Image size 2212x1672: 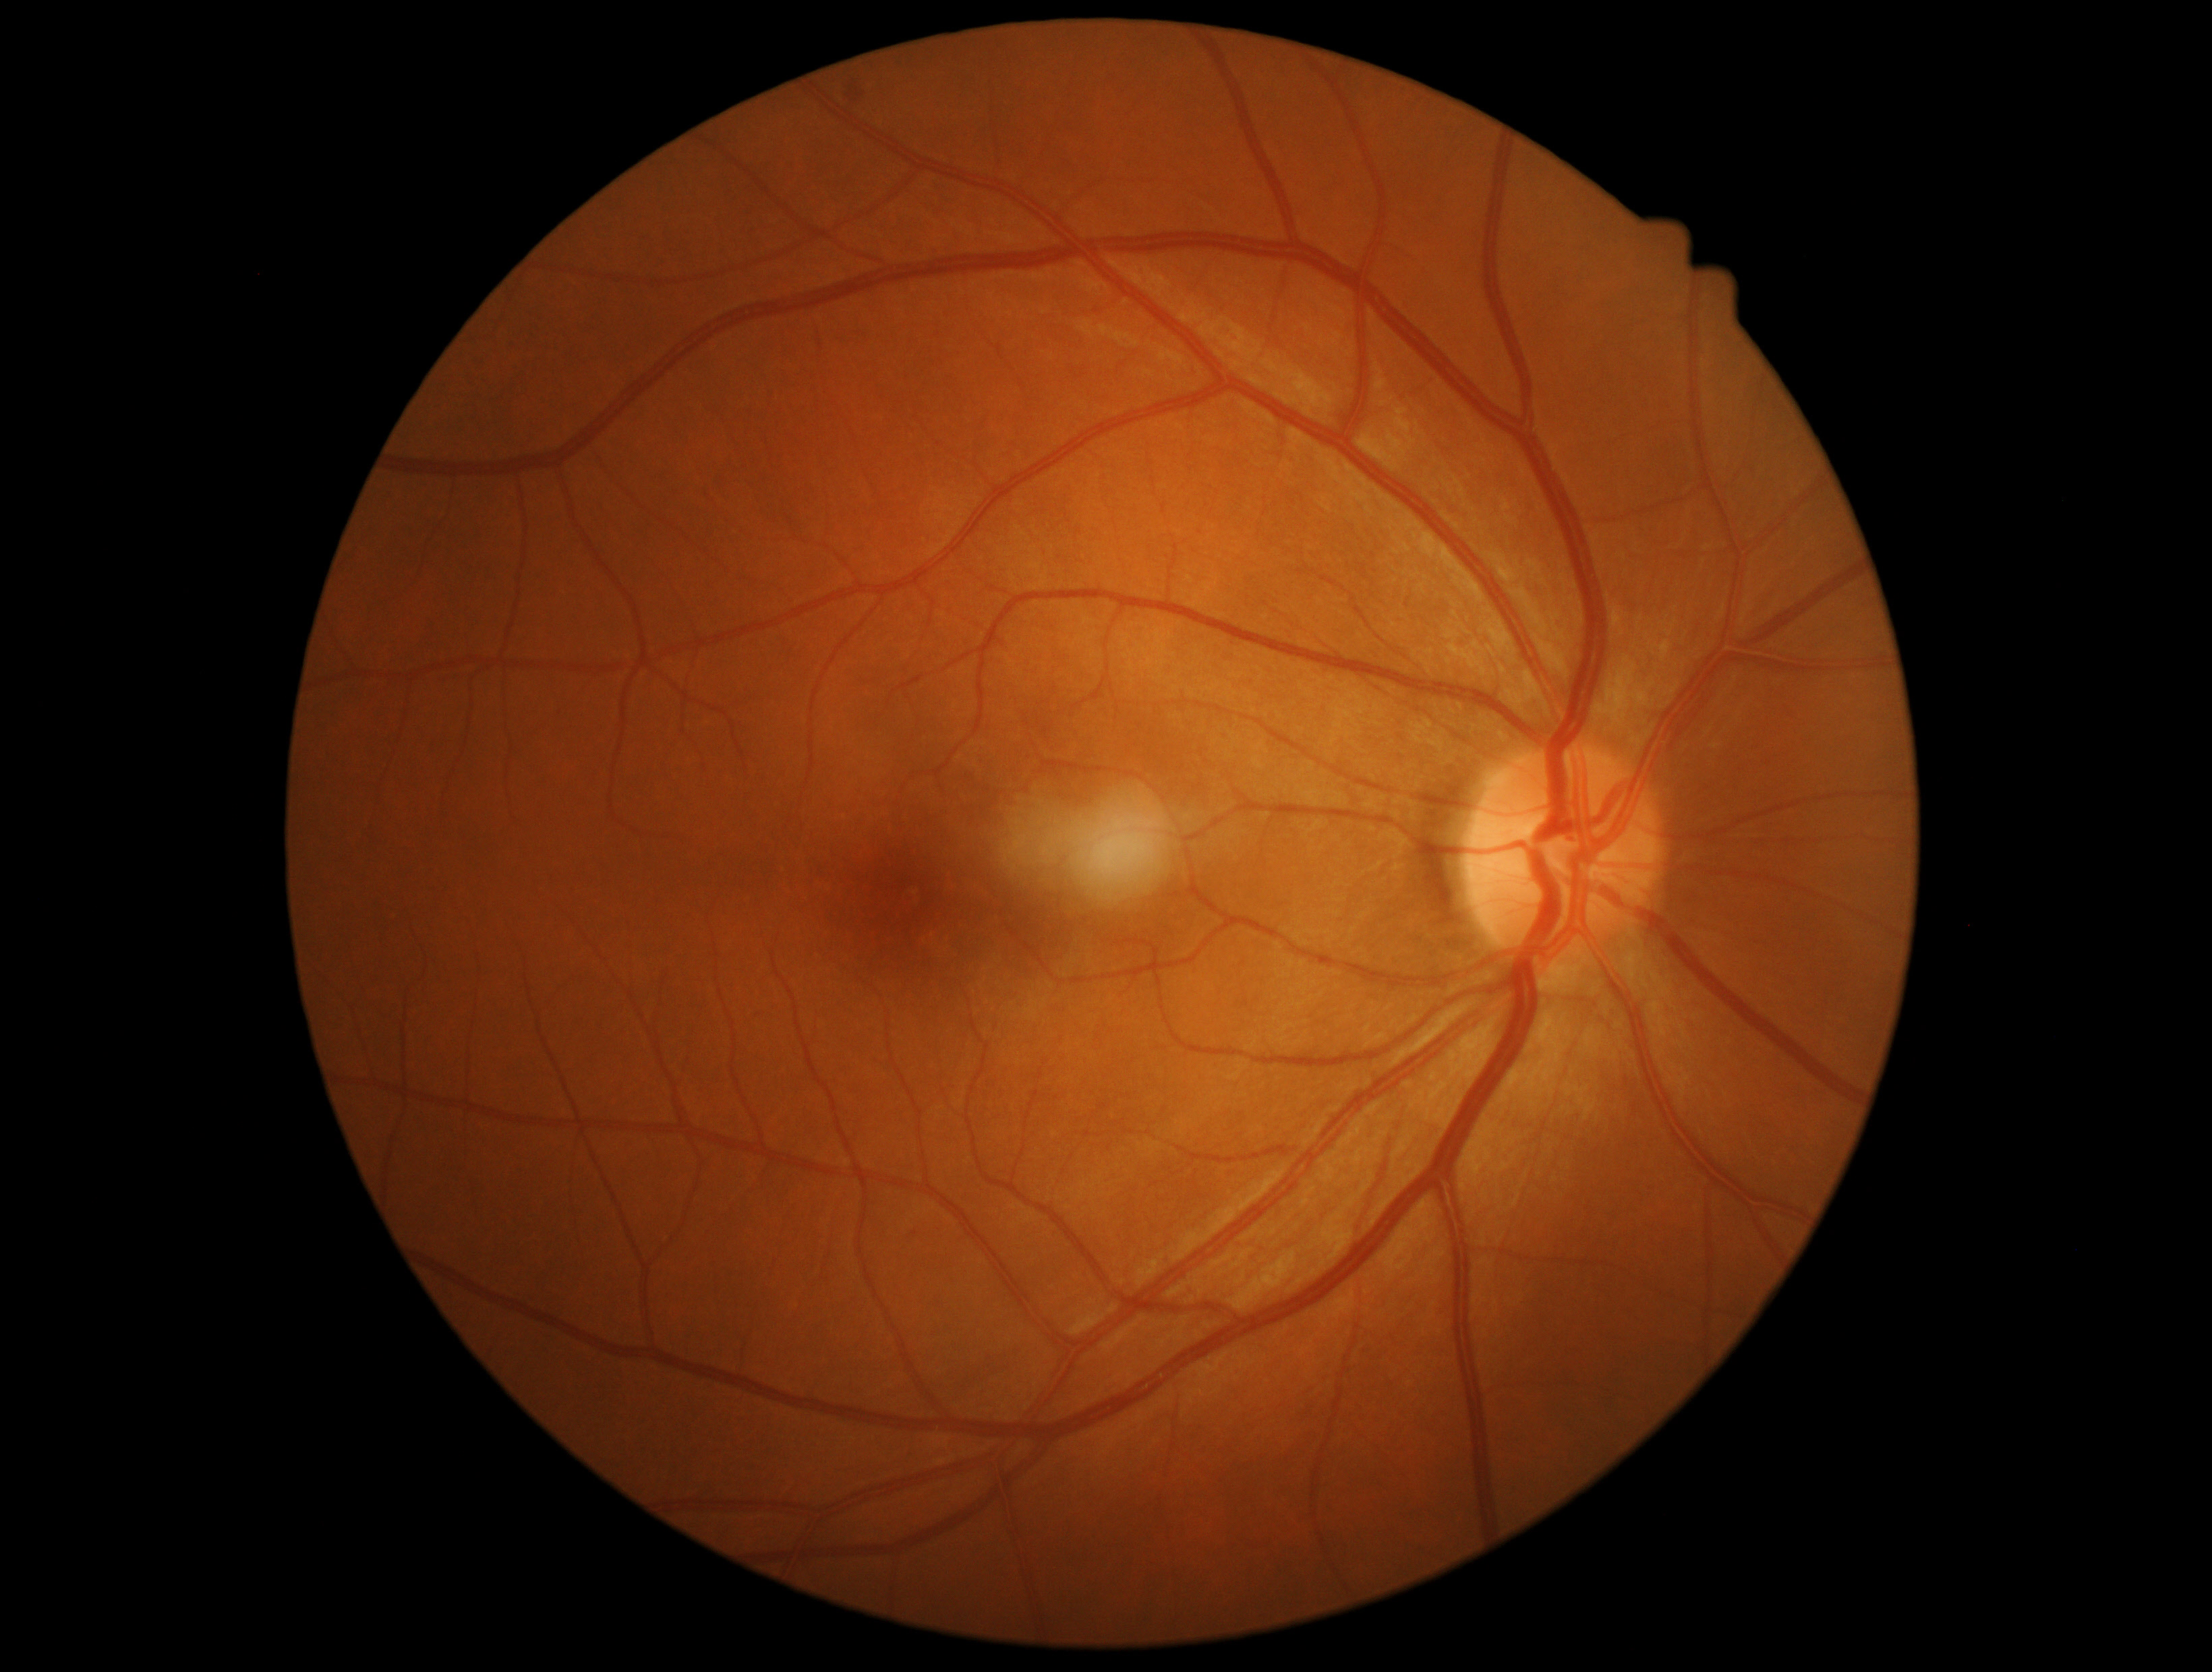

Diabetic retinopathy severity is grade 2 (moderate NPDR).